Modified Davis classification, without pupil dilation, posterior pole color fundus photograph.
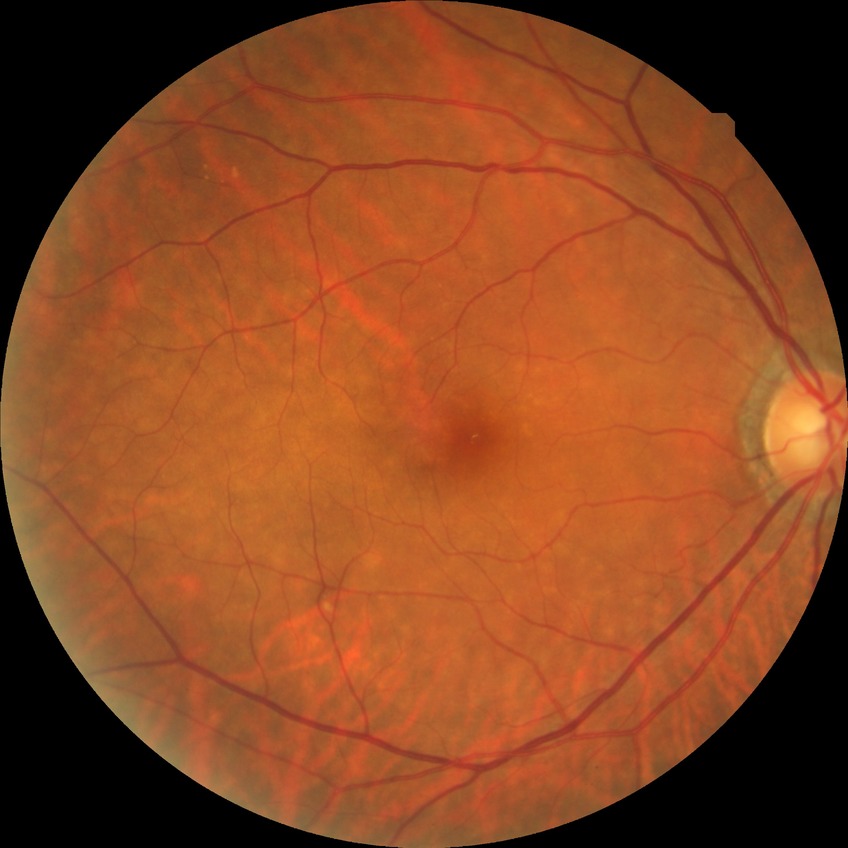 Retinopathy stage: no diabetic retinopathy.